1380x1382
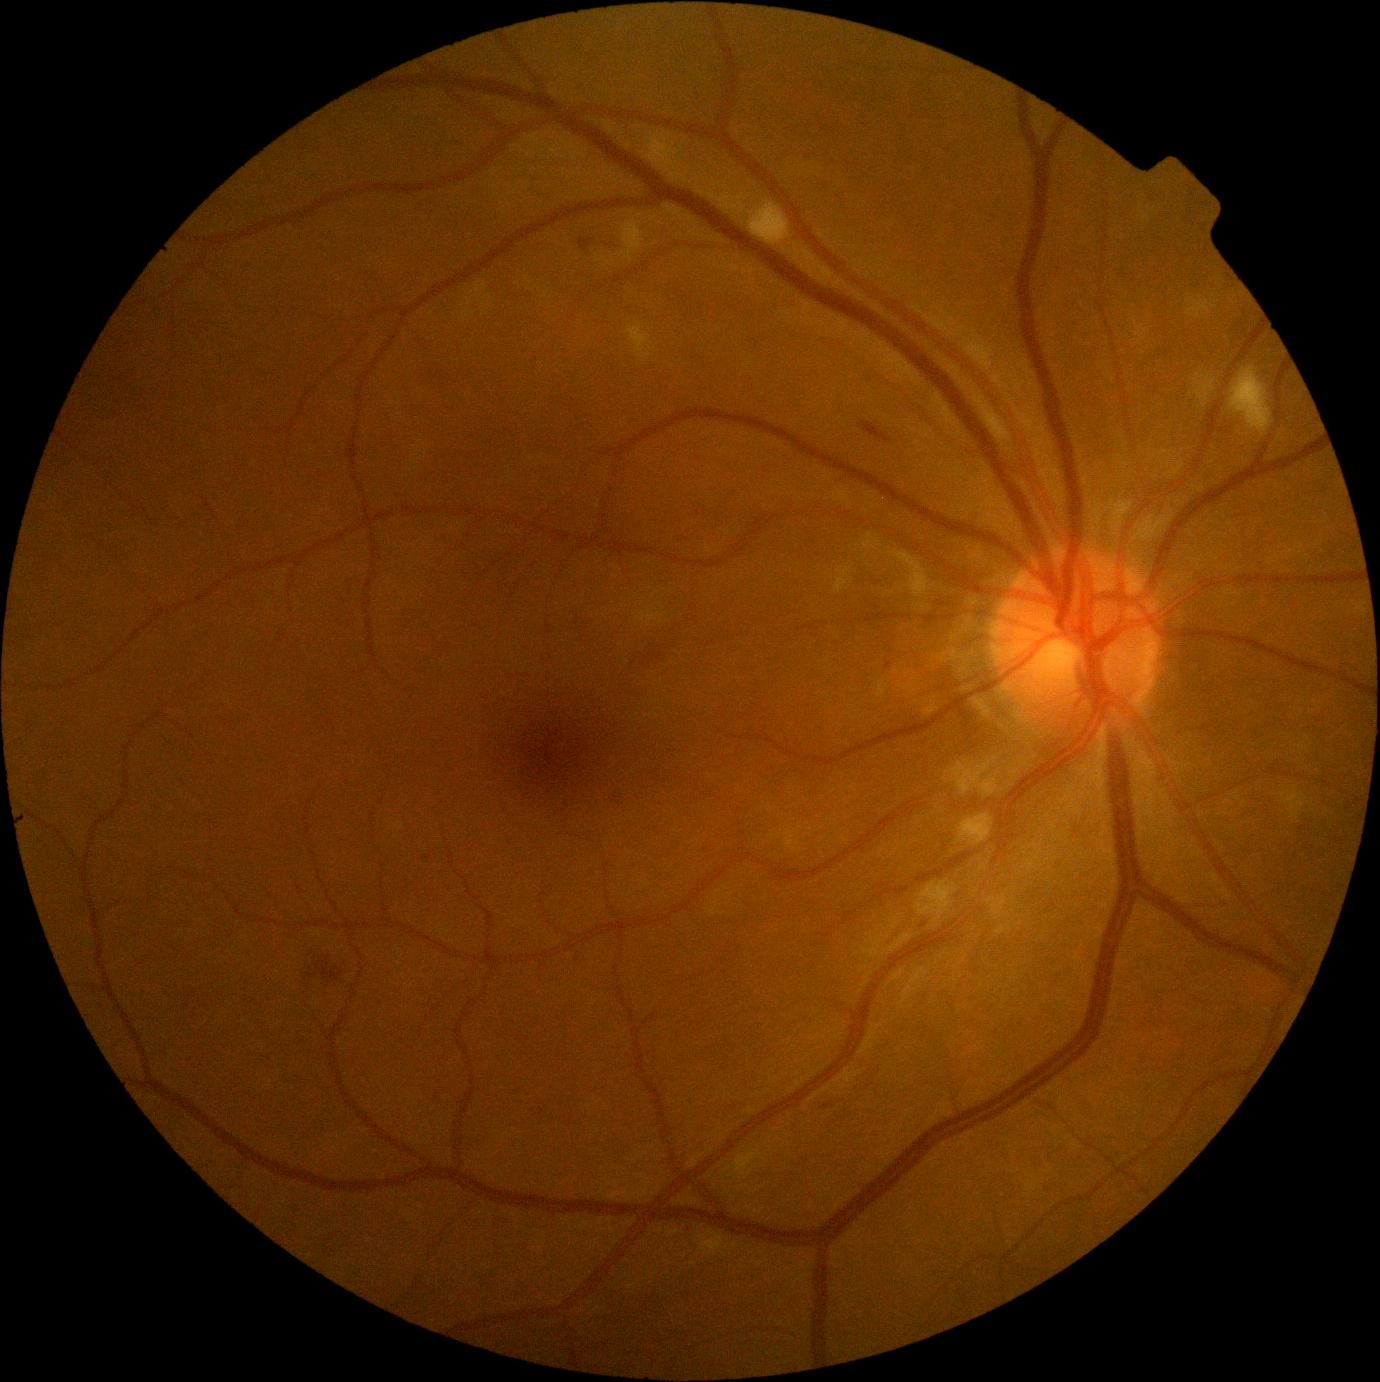

diabetic retinopathy (DR): grade 2.